Color fundus image
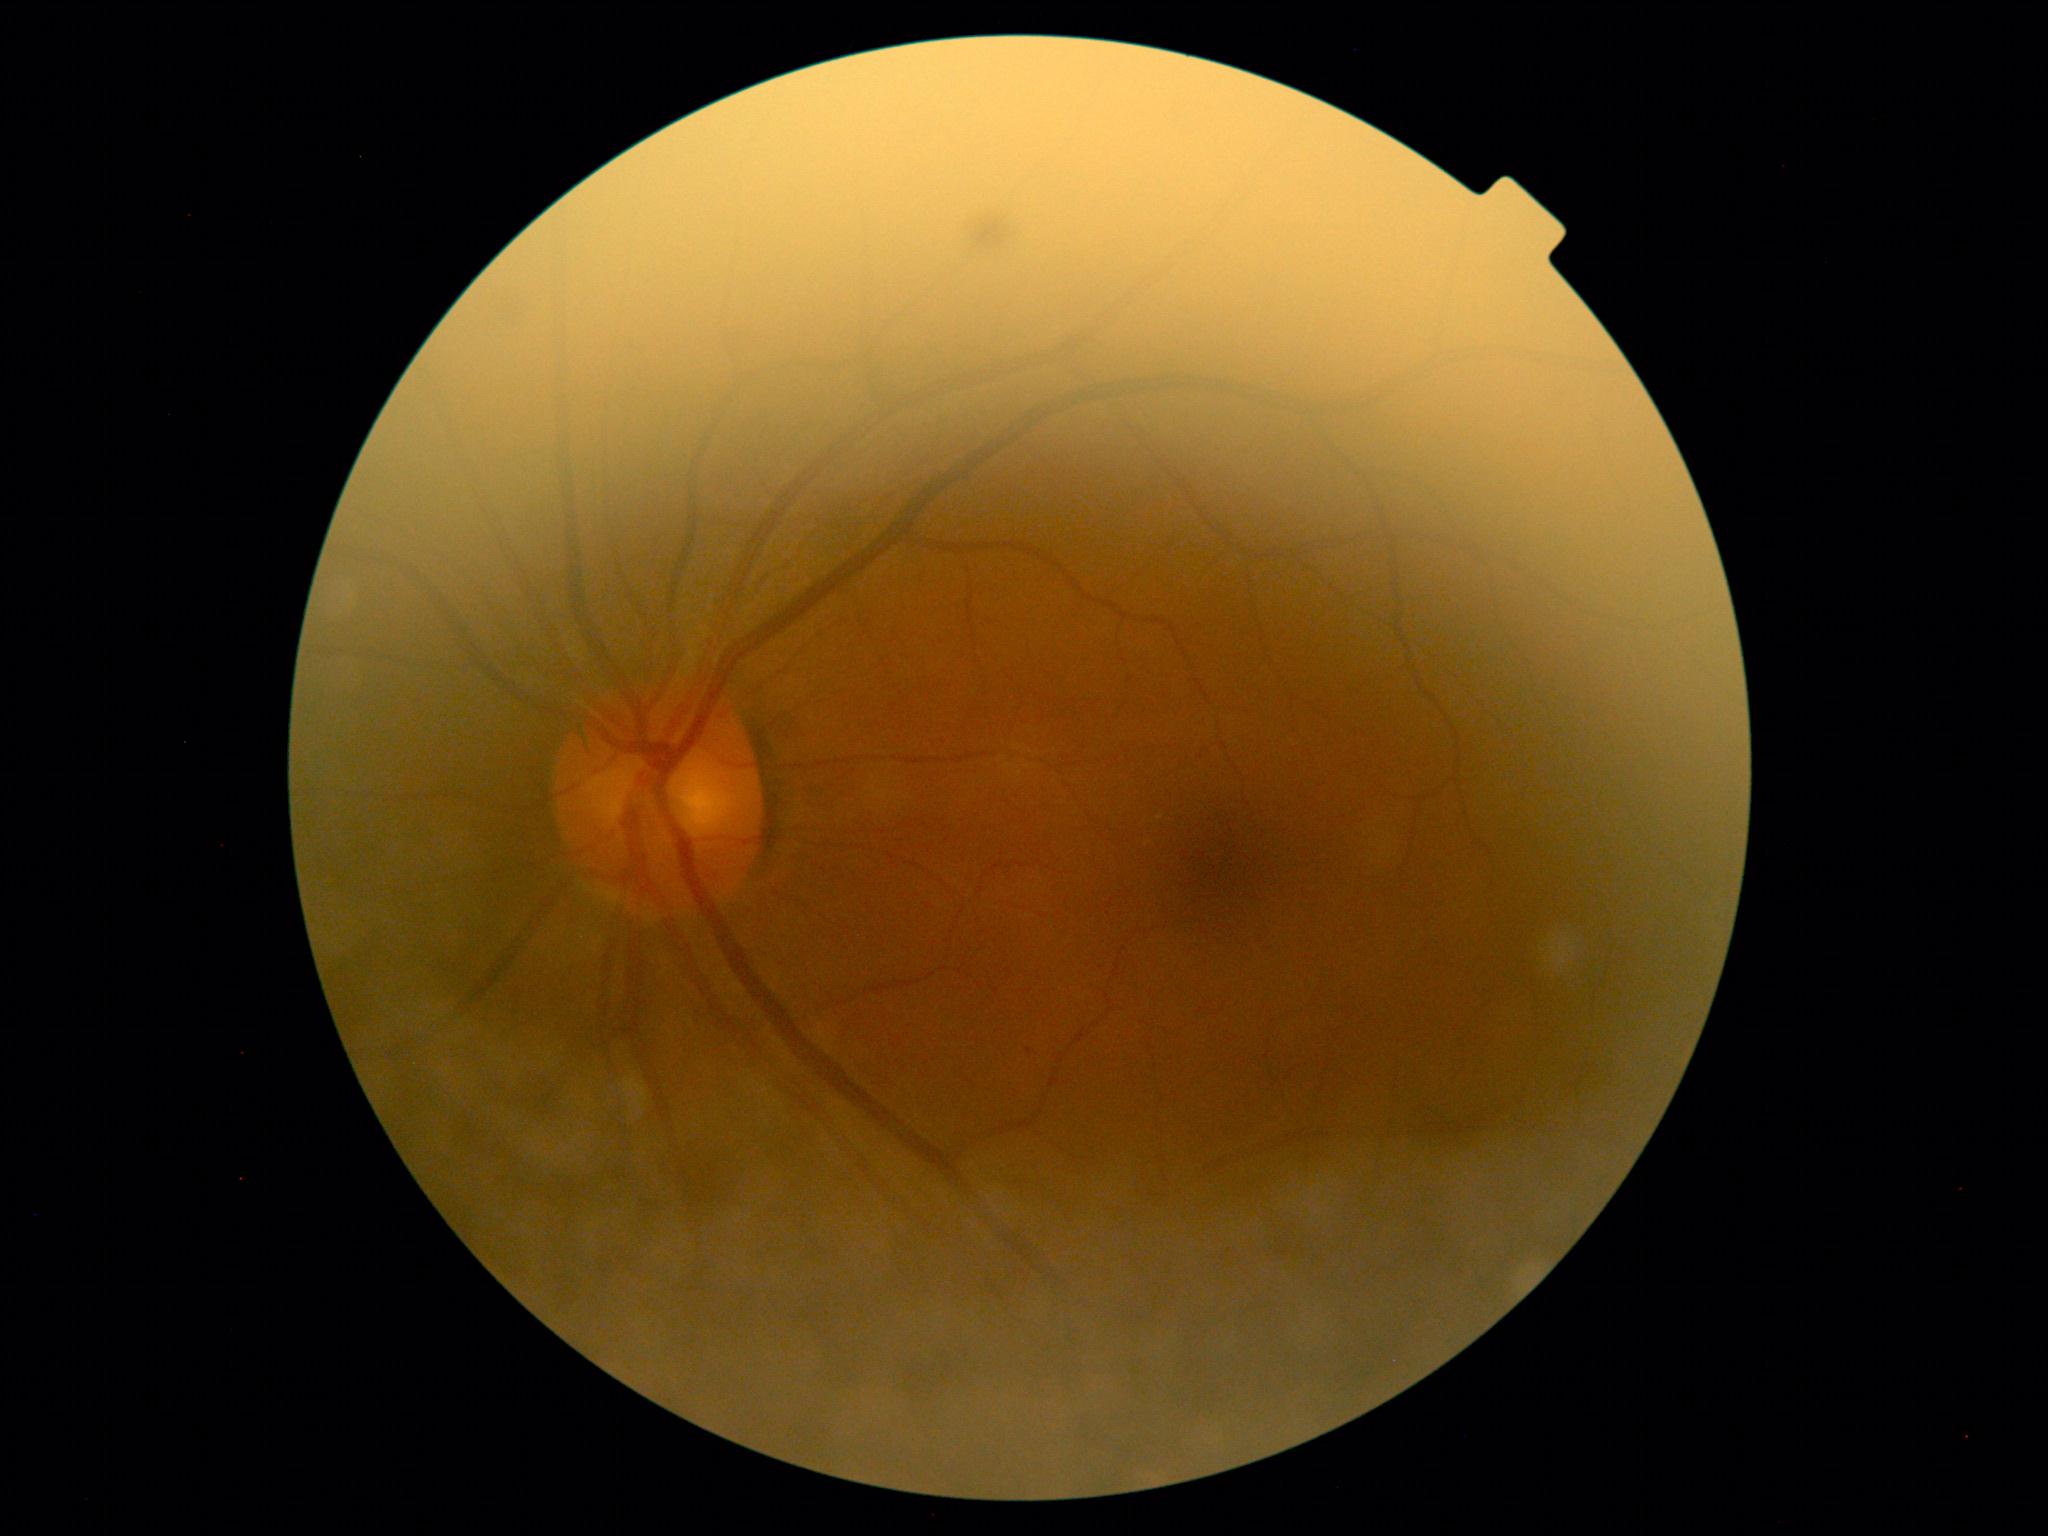
DR grade: 0 (no apparent retinopathy) — no visible signs of diabetic retinopathy.